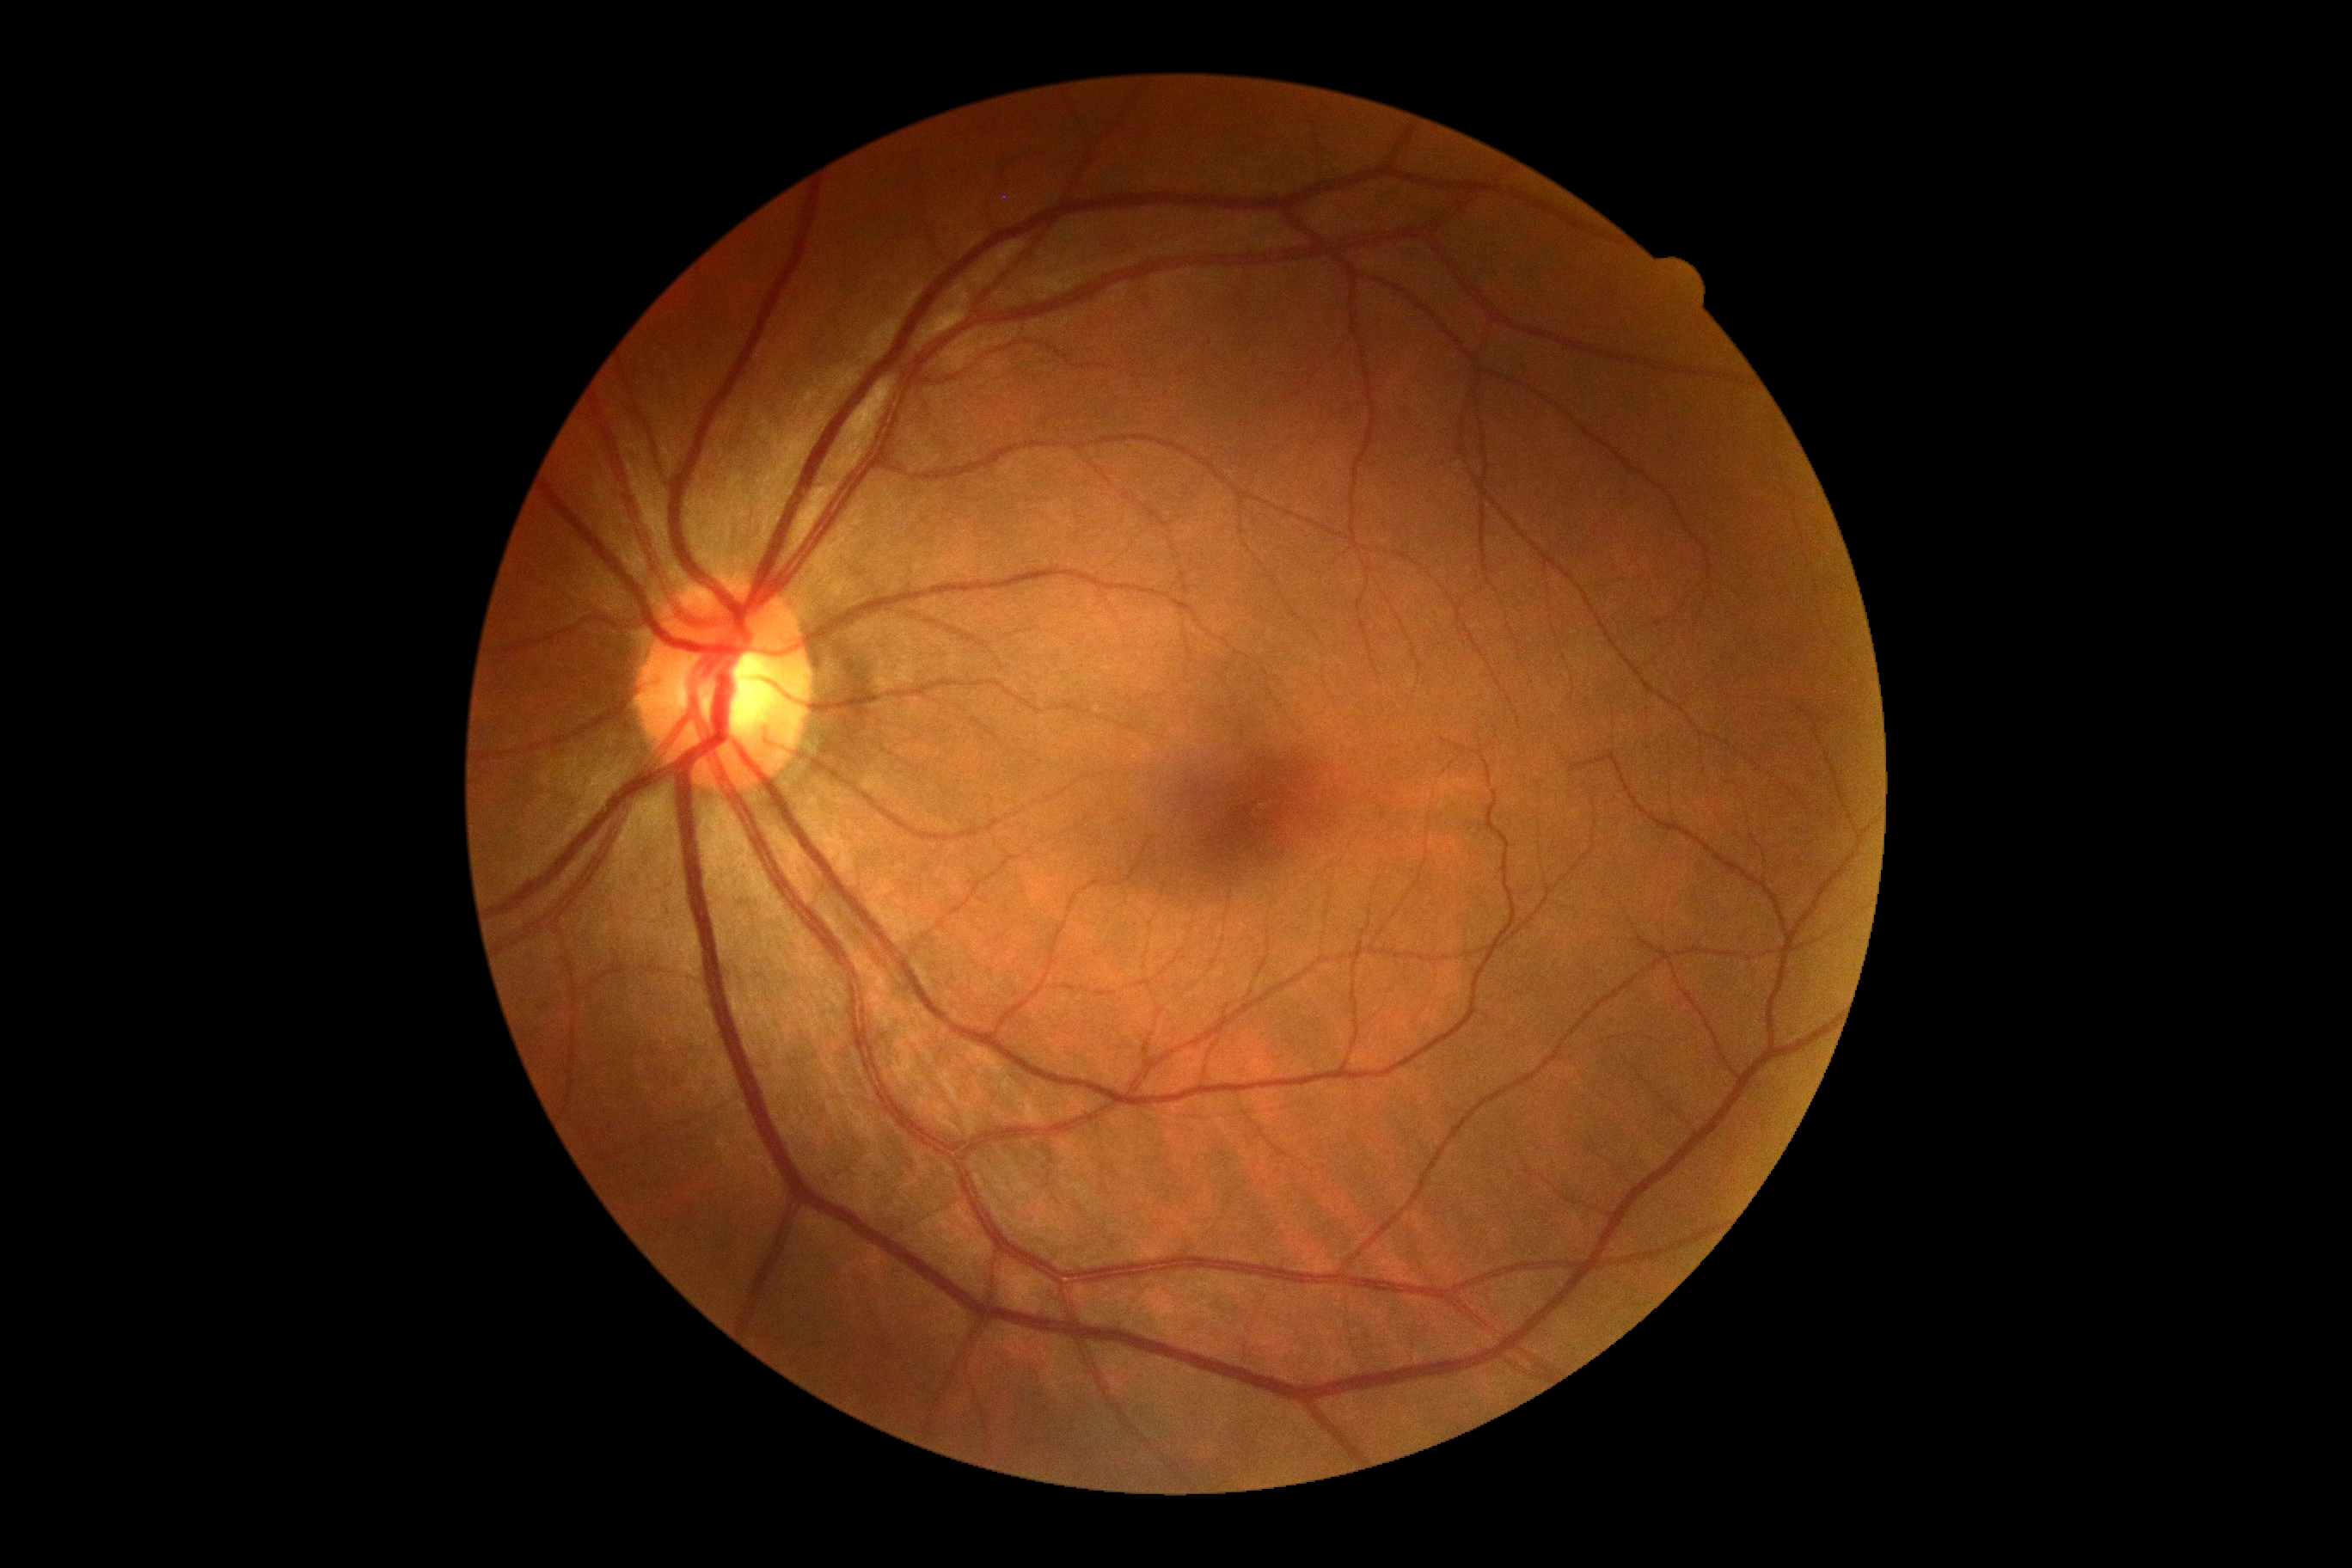 retinopathy@0/4 — no visible signs of diabetic retinopathy, DR impression@no apparent DR.